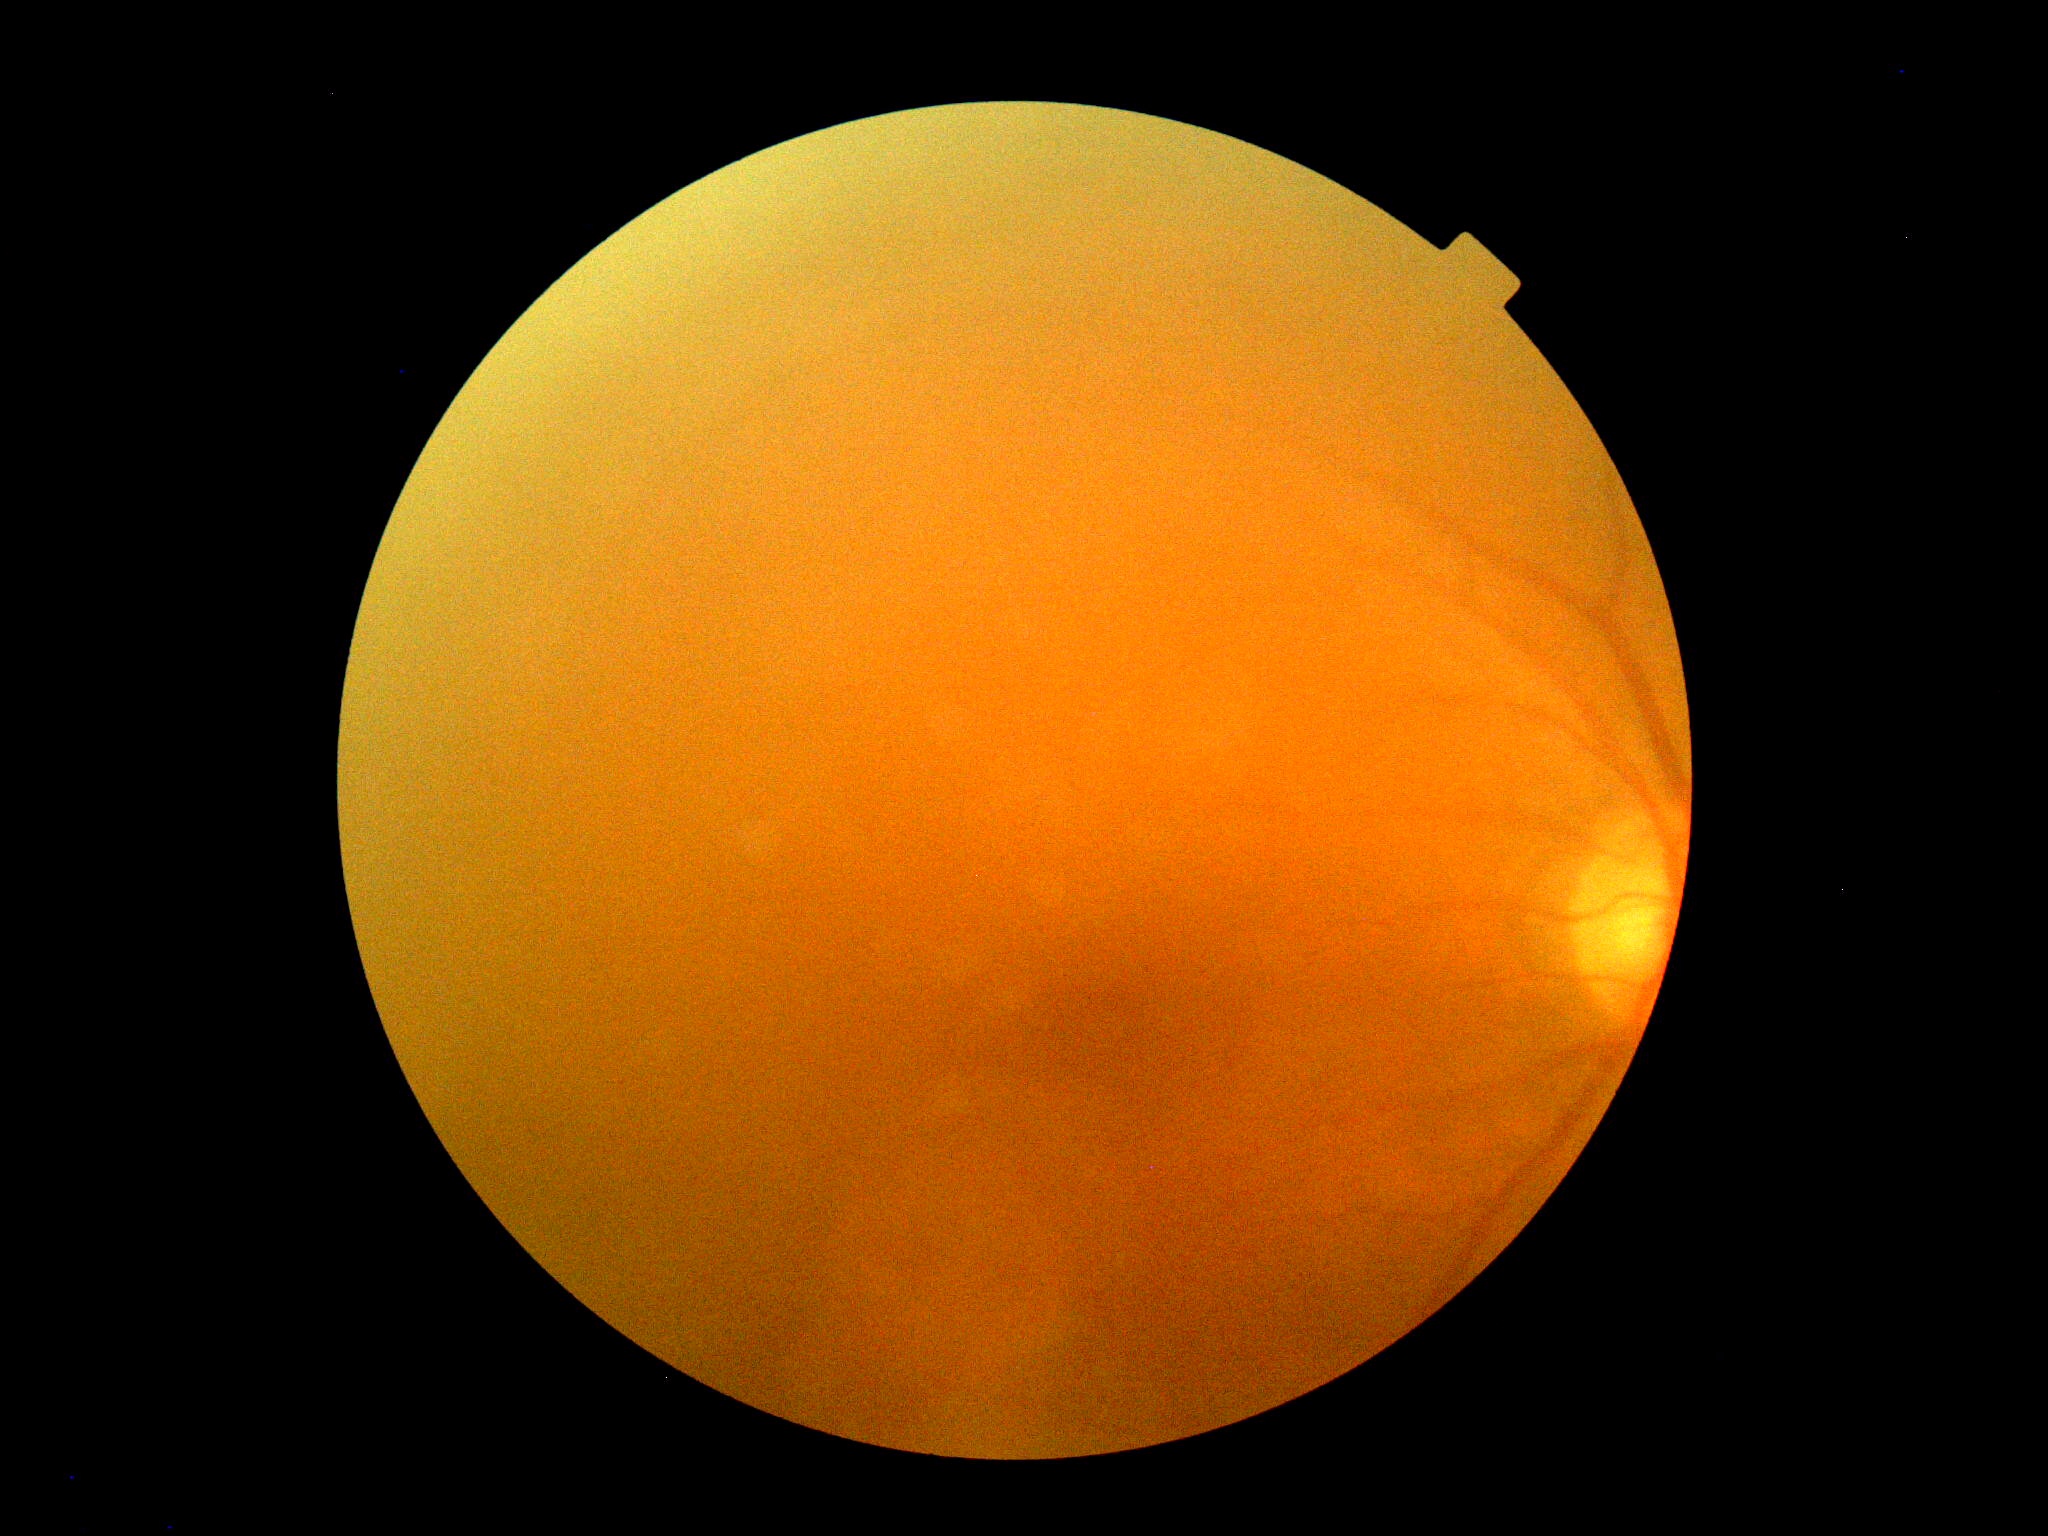 retinopathy: ungradable